Camera: Clarity RetCam 3 (130° FOV) · wide-field fundus photograph of an infant · 640x480px:
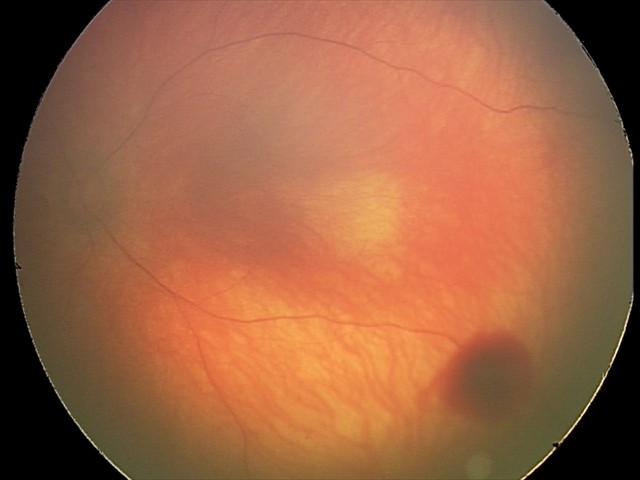
From an examination with diagnosis of retinal hemorrhages.